Fundus photo taken with a portable handheld camera.
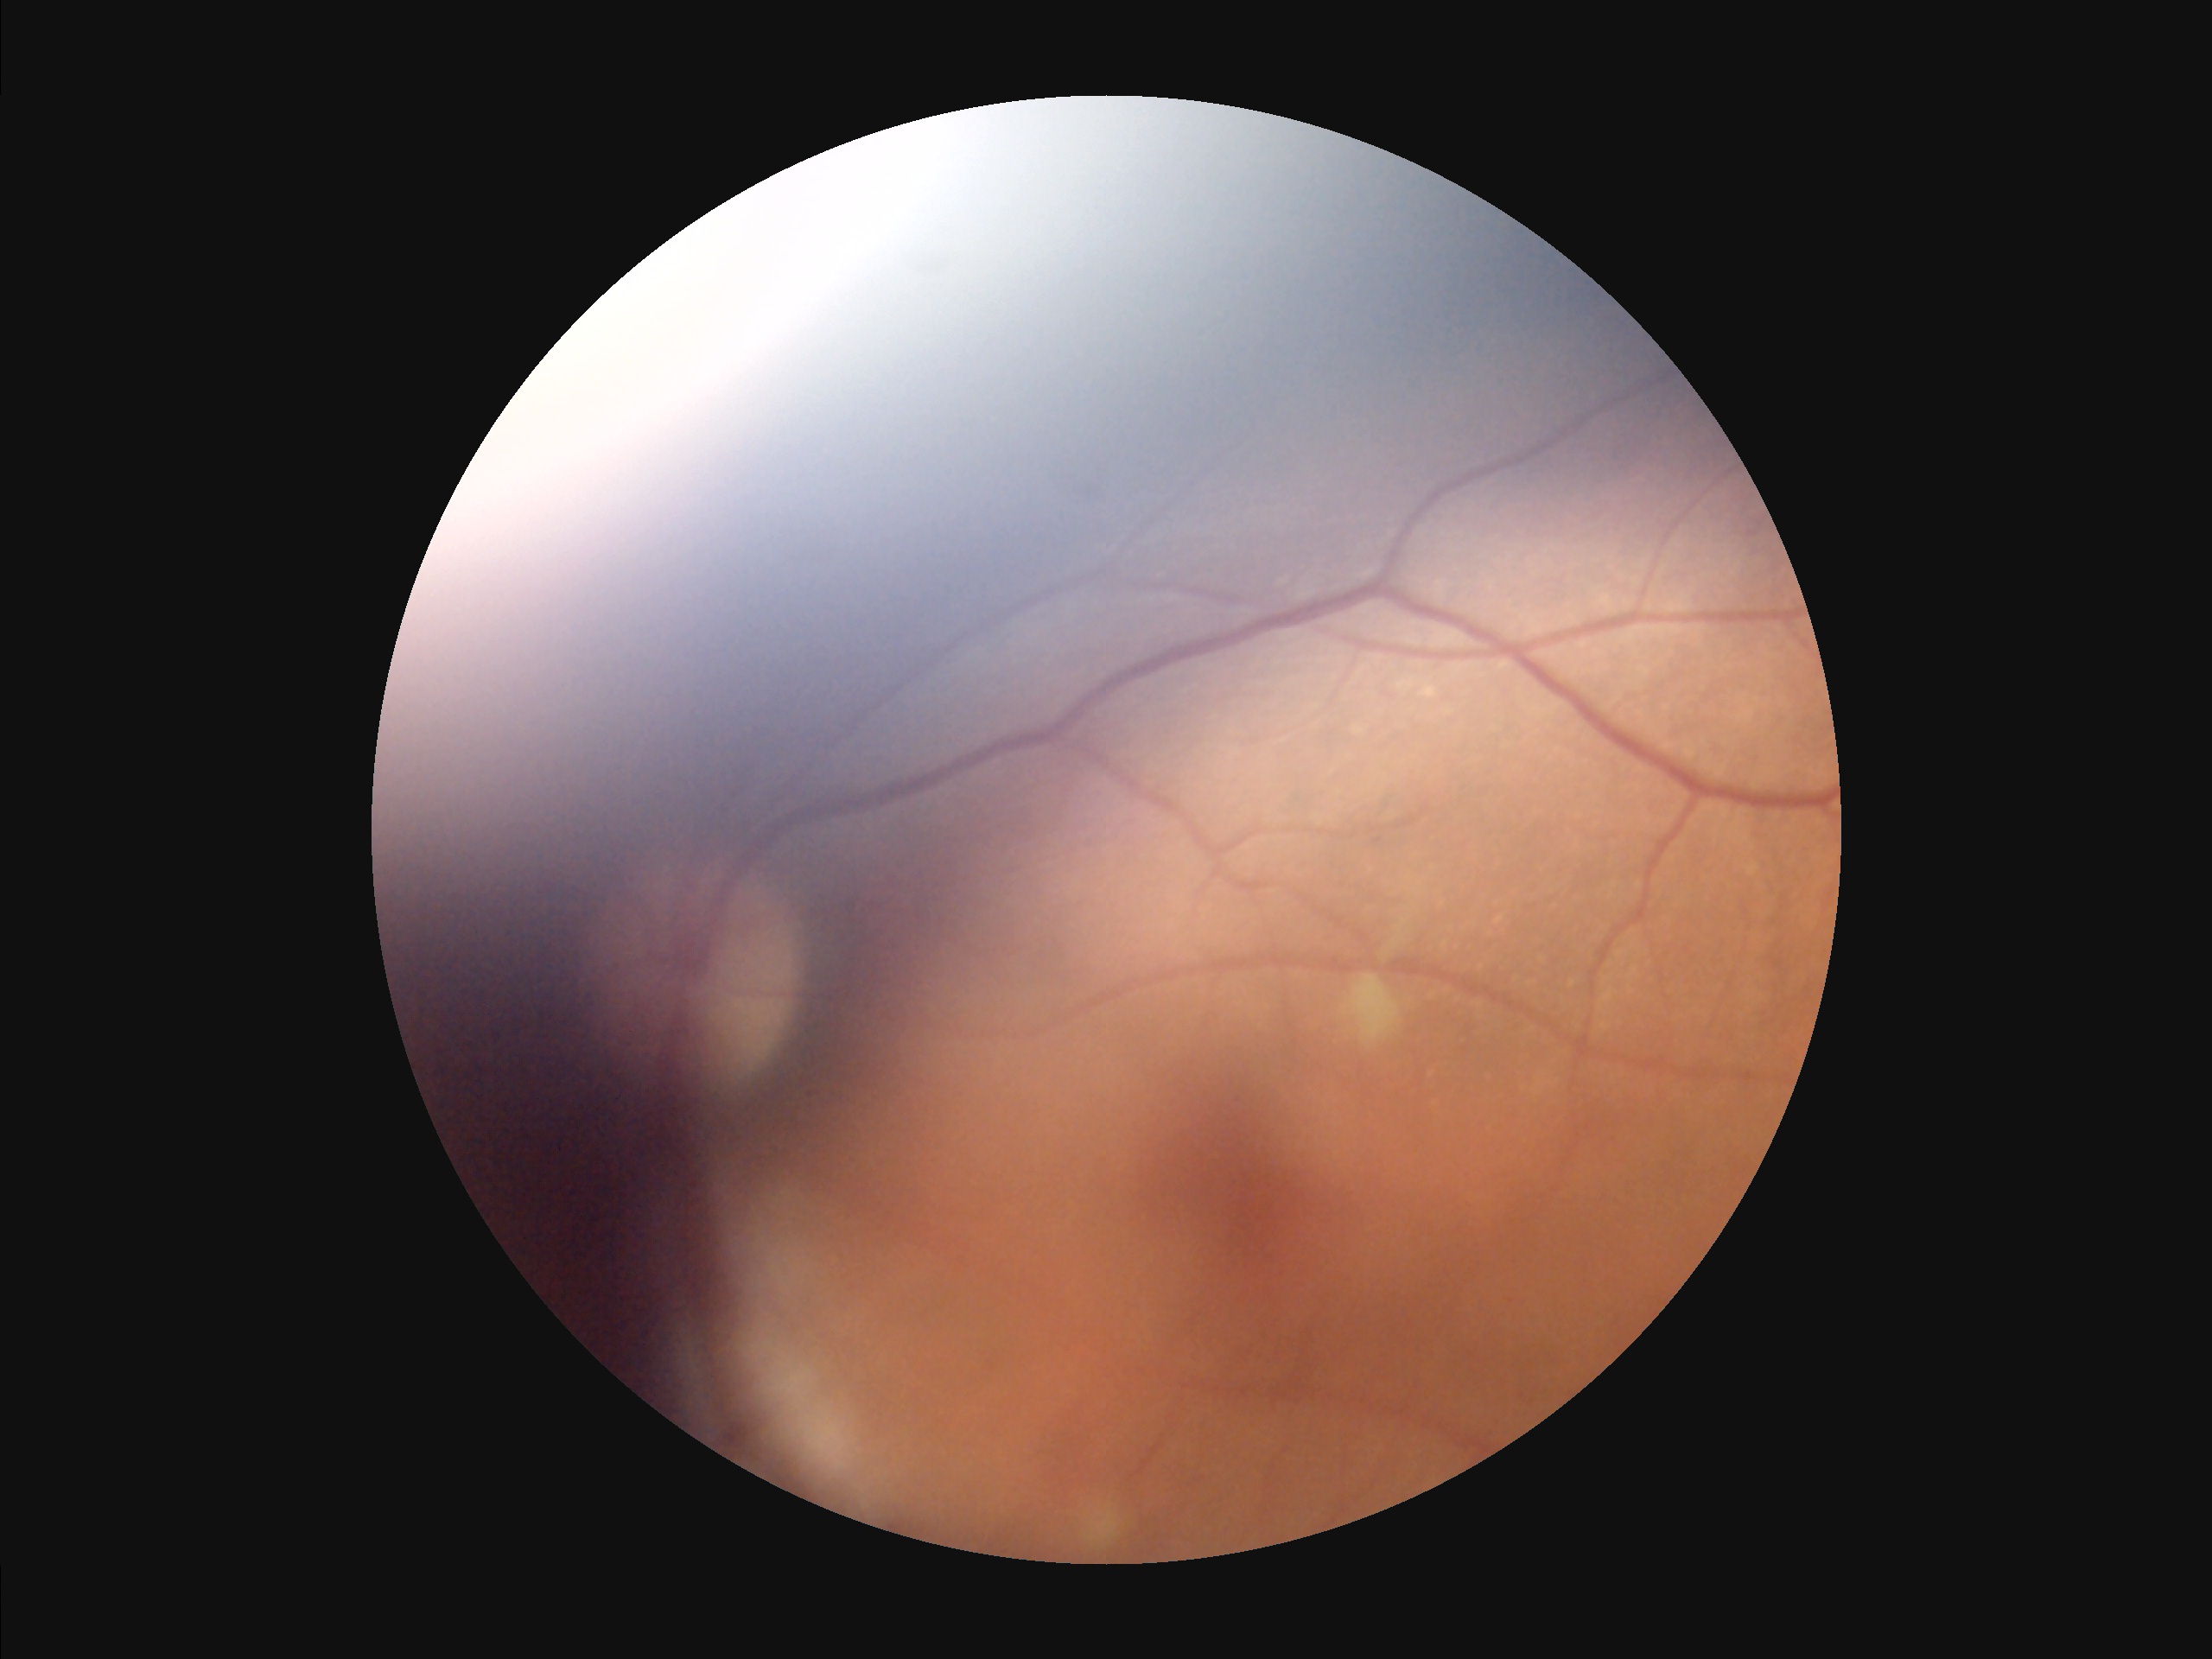
Contrast is low. Poor illumination with uneven exposure. The image is blurry. Image quality is suboptimal.